Wide-field fundus photograph from neonatal ROP screening — 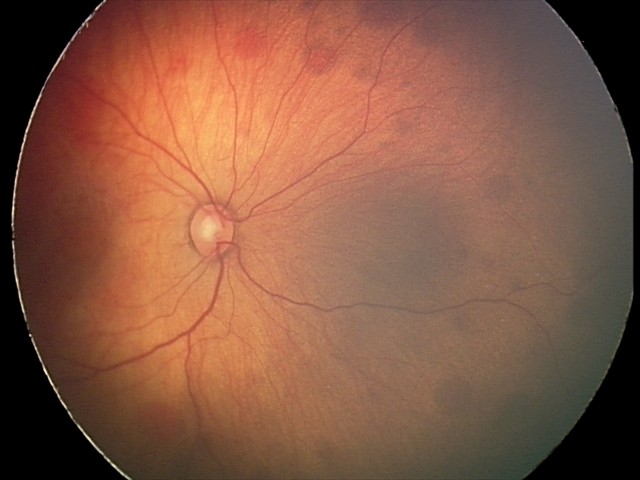

Screening diagnosis: retinal hemorrhages.